Phoenix ICON, 100° FOV · infant wide-field fundus photograph · 1240 by 1240 pixels — 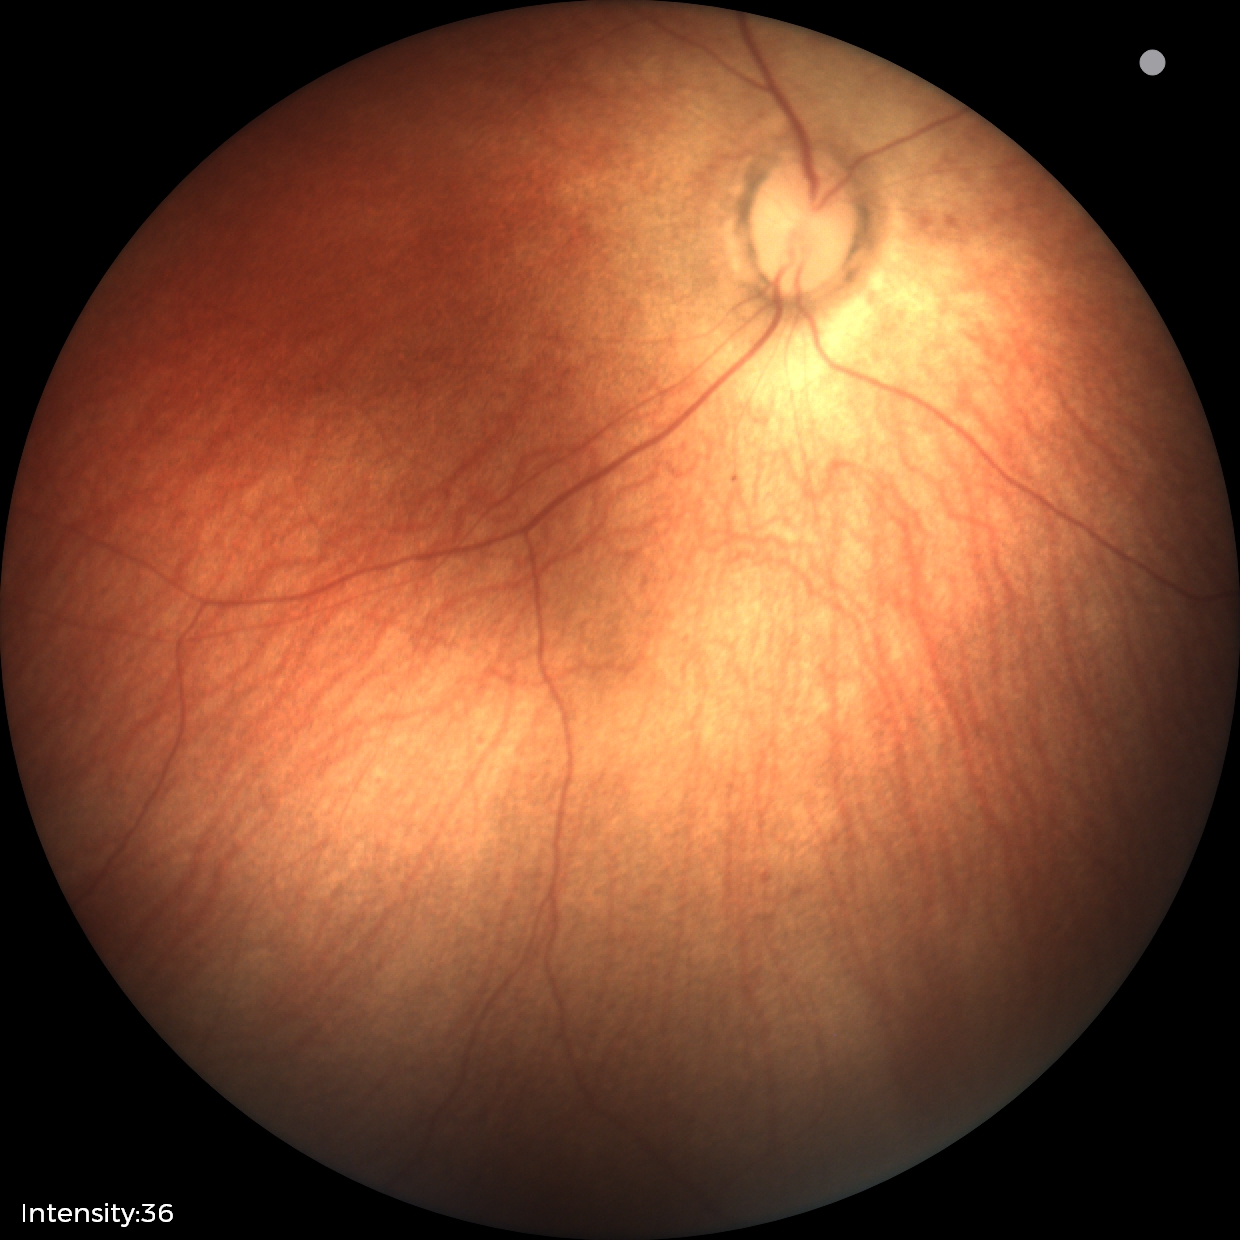 Examination with physiological retinal findings.